CFP:
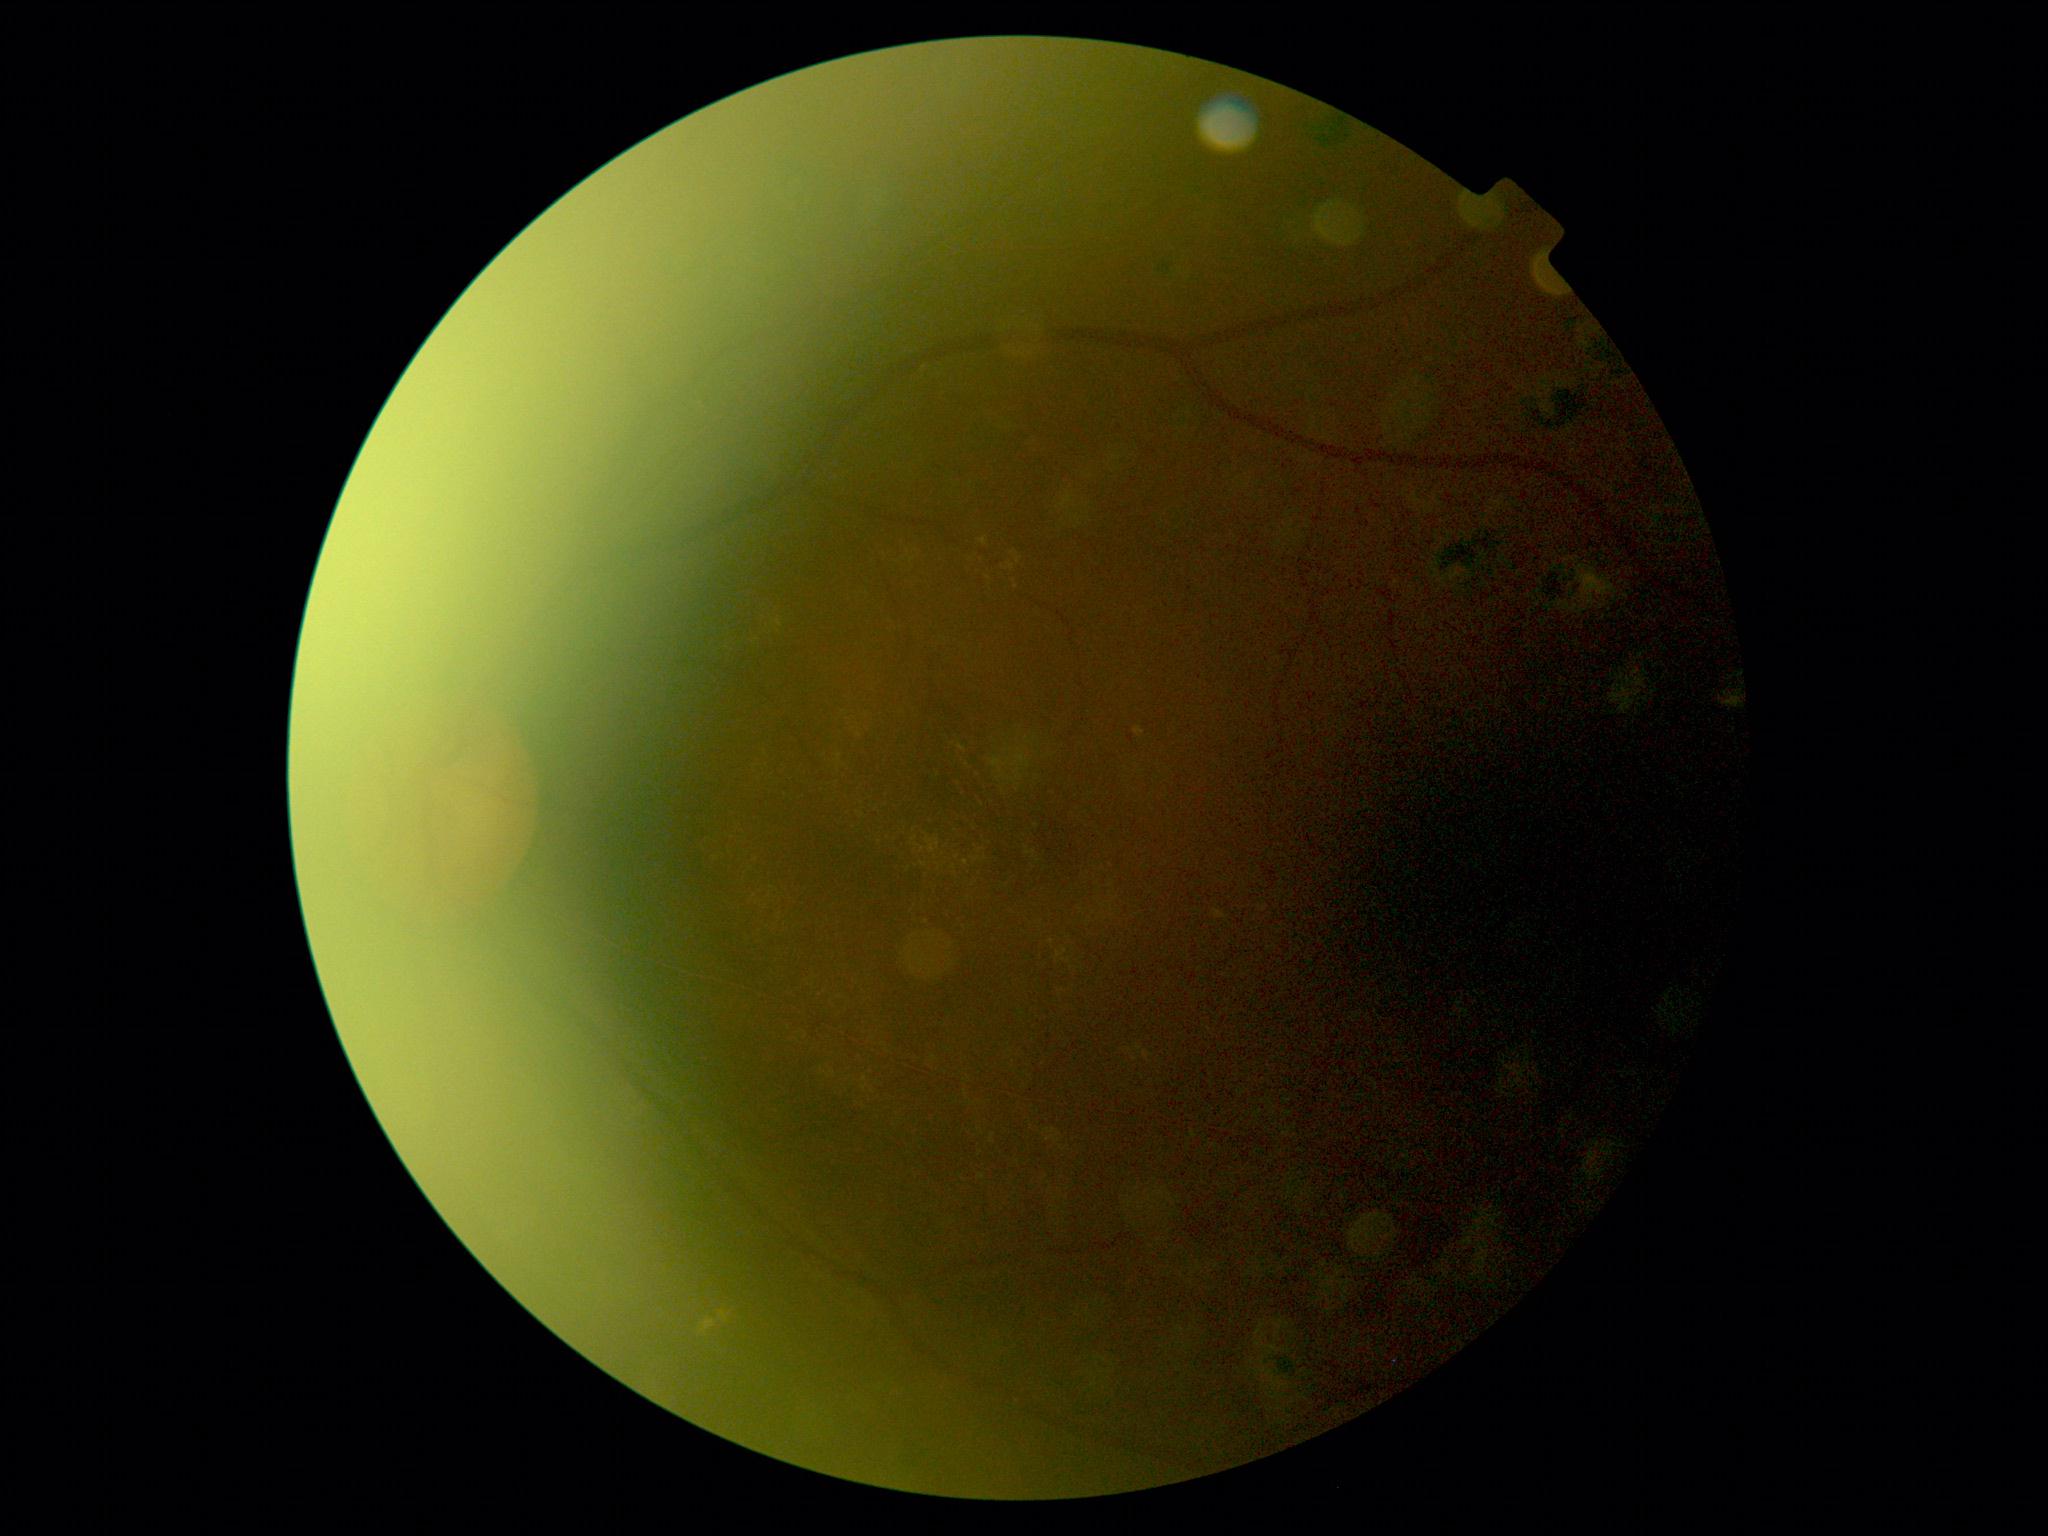

{"dr_grade": "moderate NPDR (grade 2)"}